Without pupil dilation. 45° FOV. Graded on the modified Davis scale. NIDEK AFC-230 fundus camera
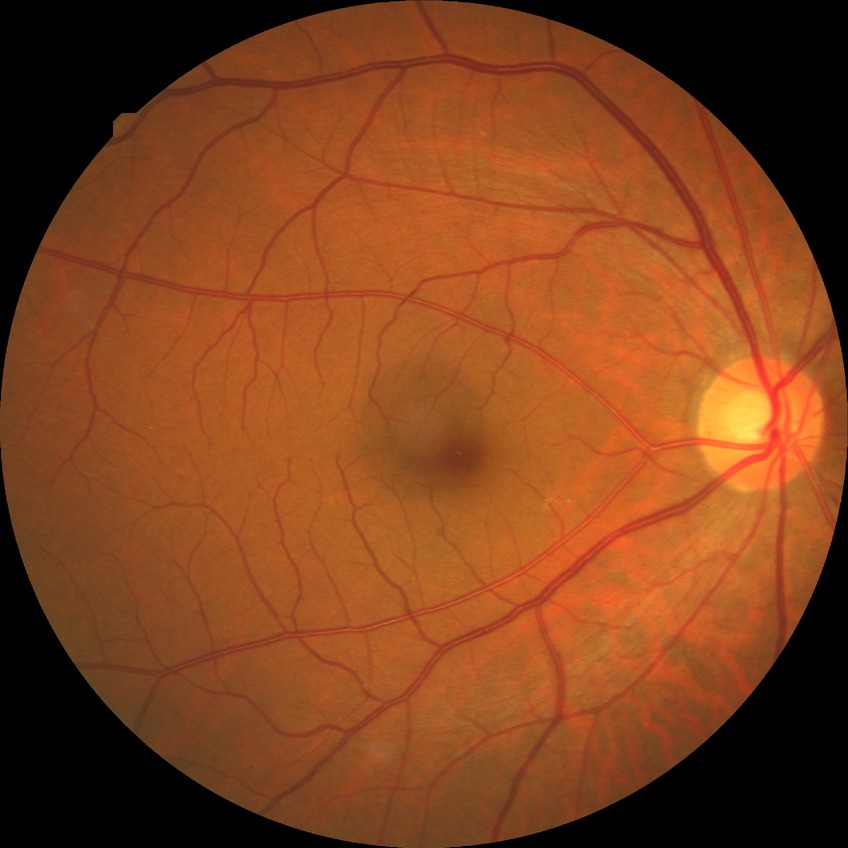
diabetic retinopathy (DR) = no diabetic retinopathy (NDR).